Wide-field fundus image from infant ROP screening; 640 x 480 pixels
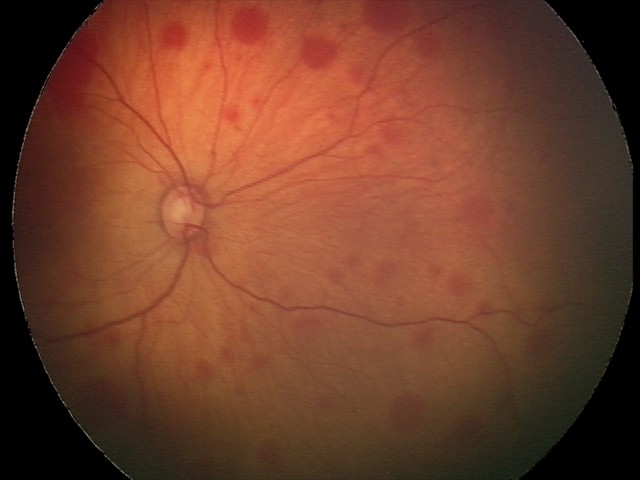

Diagnosis = retinal hemorrhages.